2228 by 1652 pixels · 50-degree field of view · central posterior field · Topcon TRC-50DX · pupil-dilated · fundus photo — 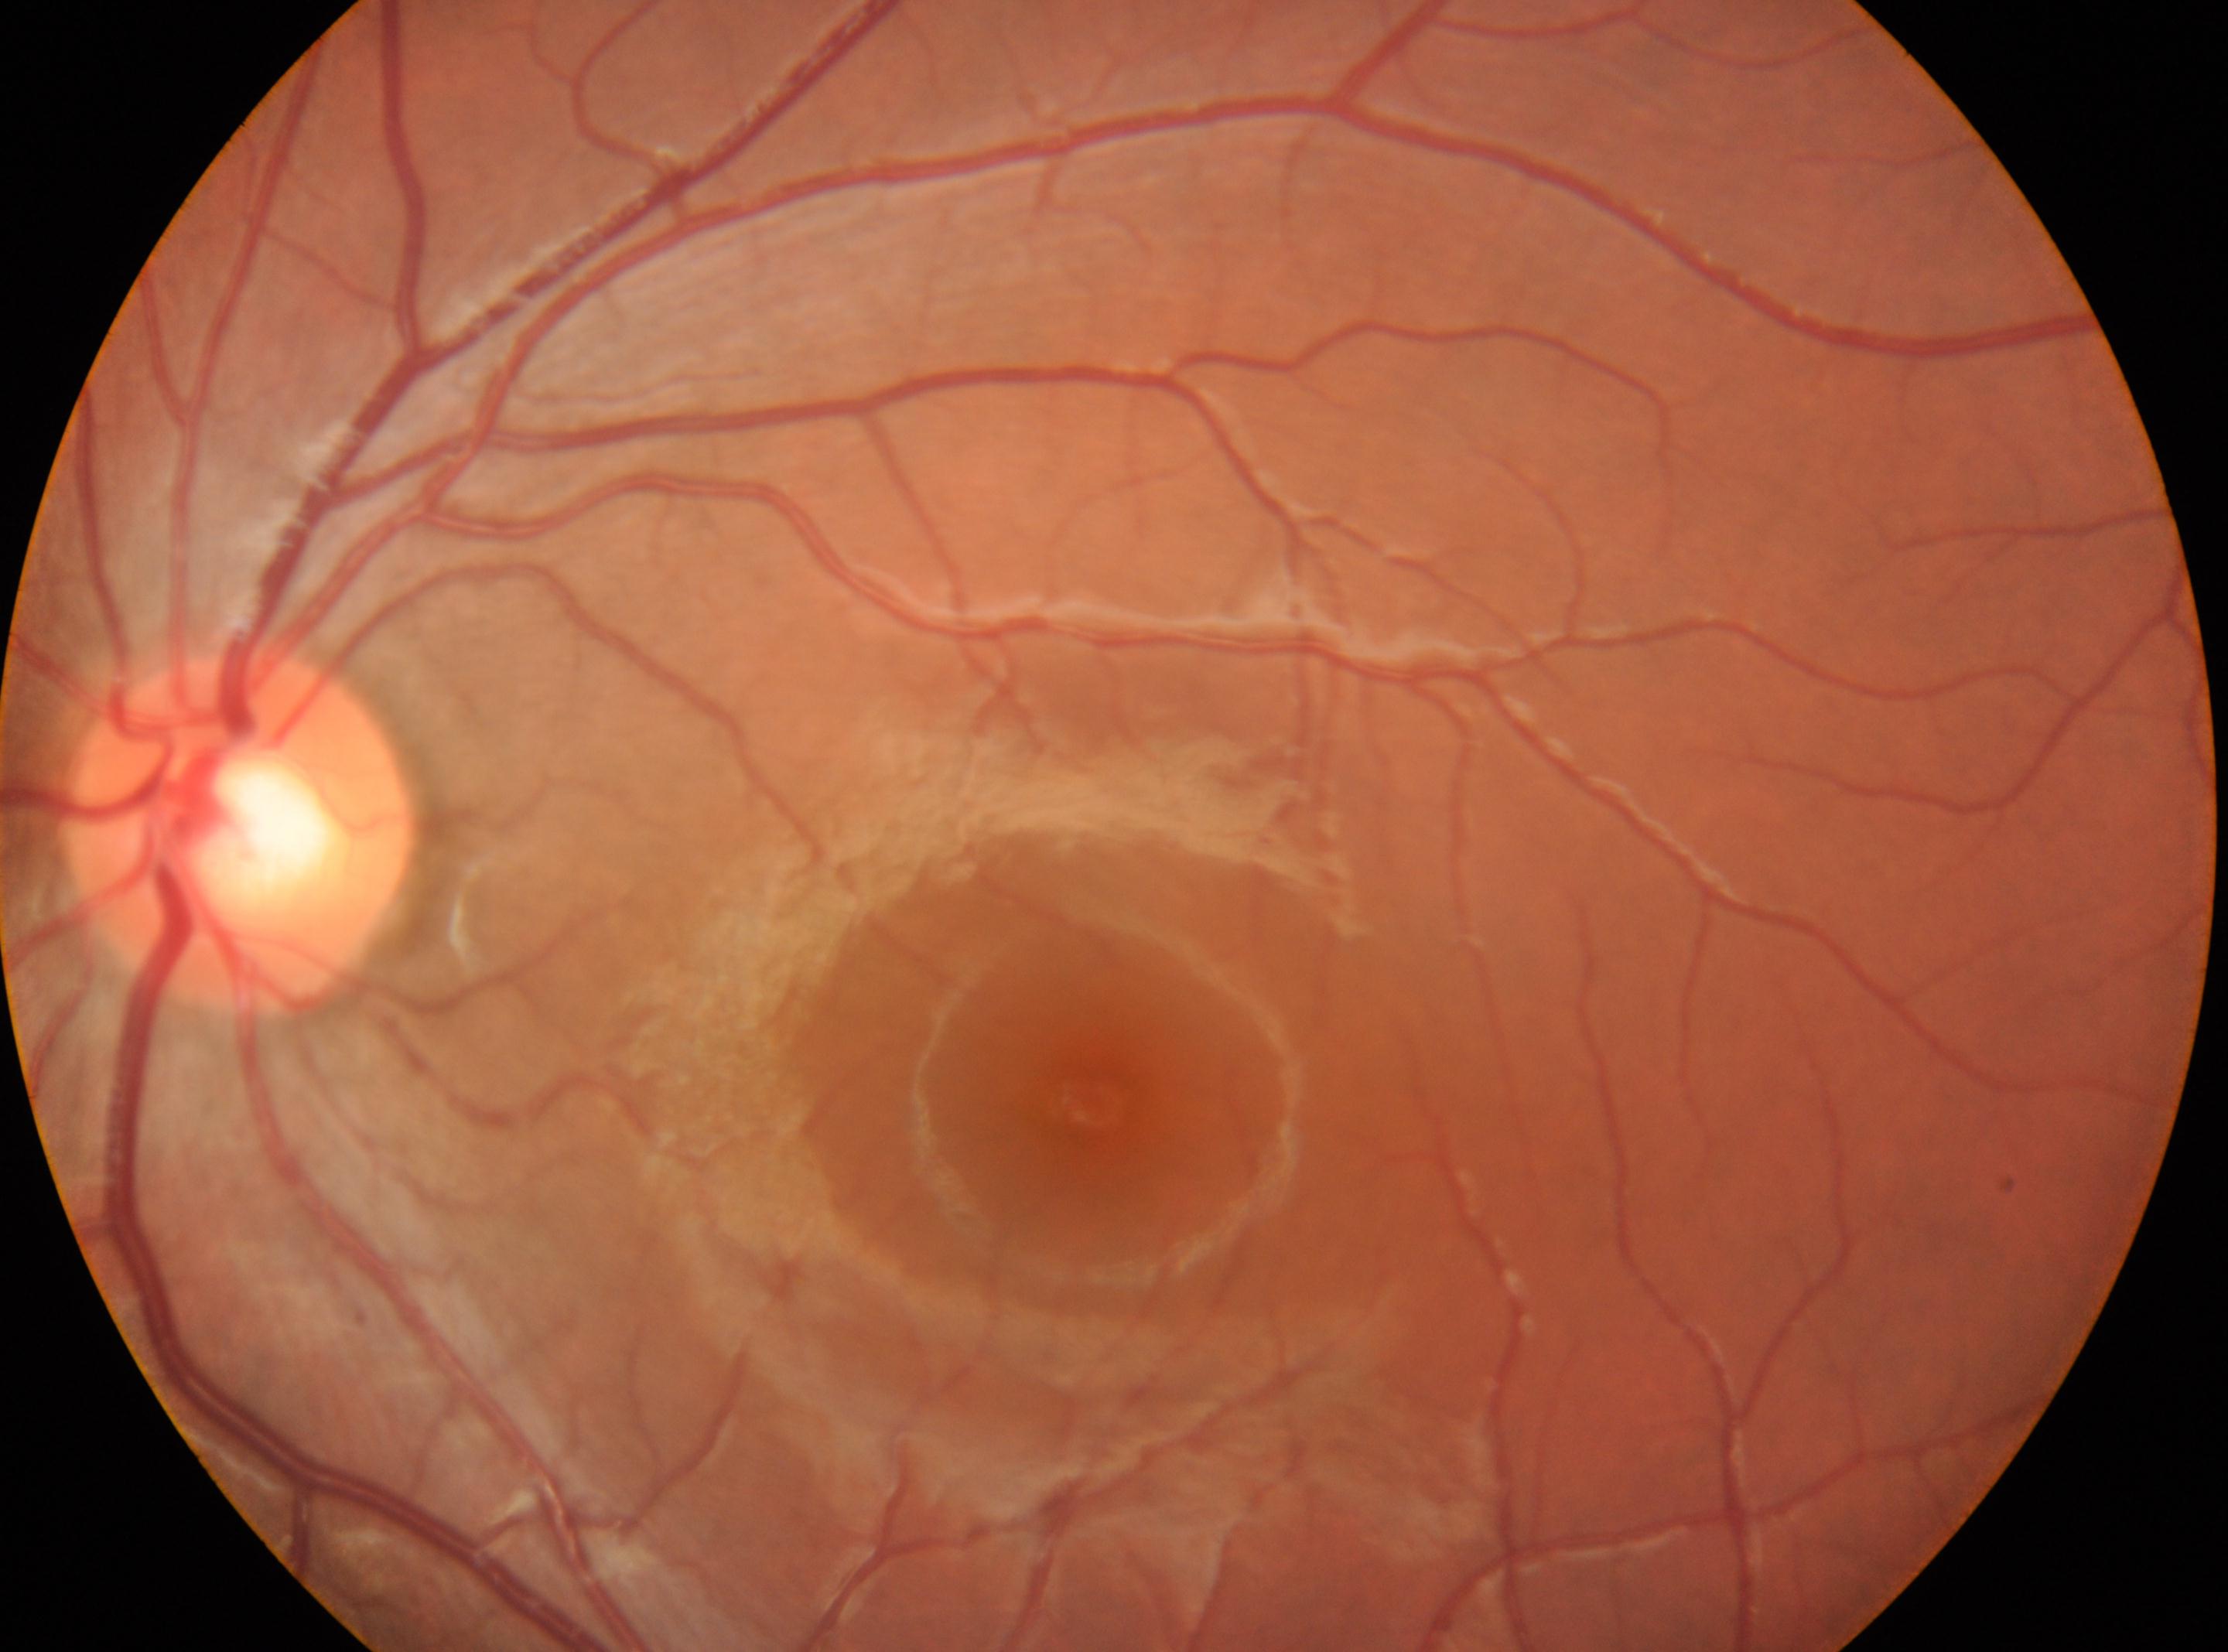

Annotations:
• macula center: x=1092, y=1104
• diabetic retinopathy: grade 0
• the optic disc: x=241, y=831
• laterality: left eye